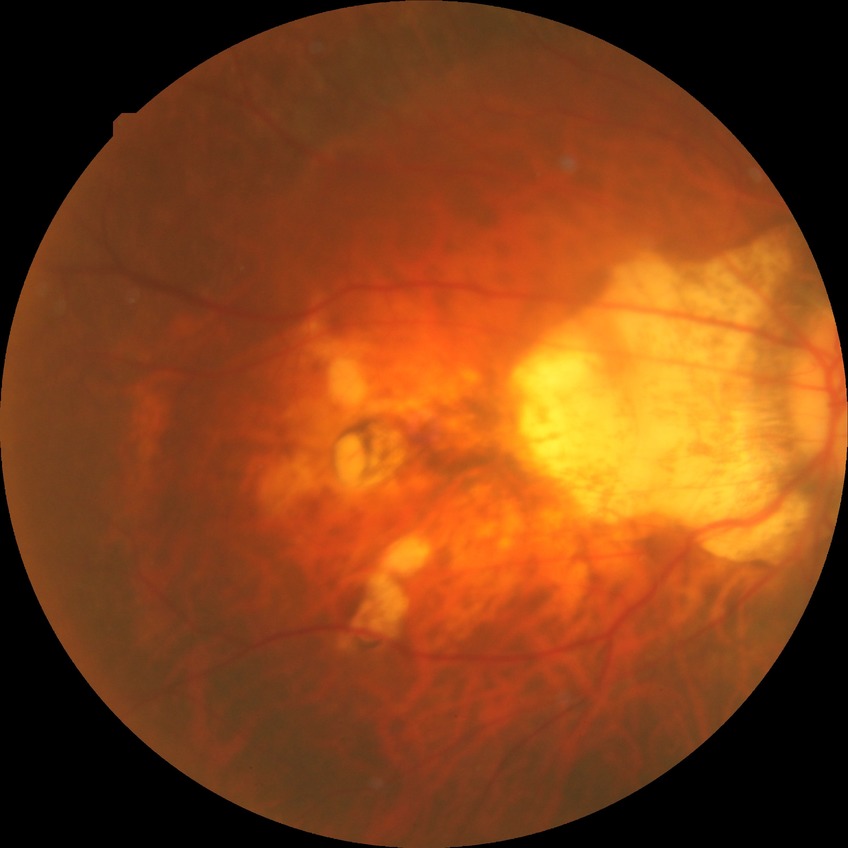
Retinopathy grade: no diabetic retinopathy.